Color fundus photograph, 45° FOV:
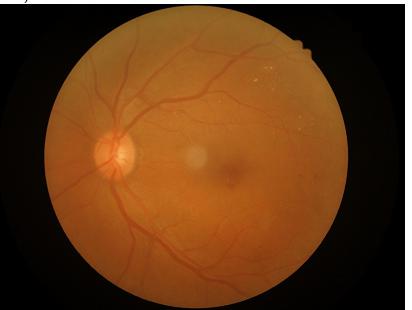 Quality grading:
- overall: adequate for clinical interpretation
- illumination: even and well-balanced
- focus: sharp throughout the field
- contrast: wide intensity range, structures distinguishable